2212x1661px; camera: Topcon TRC-NW400:
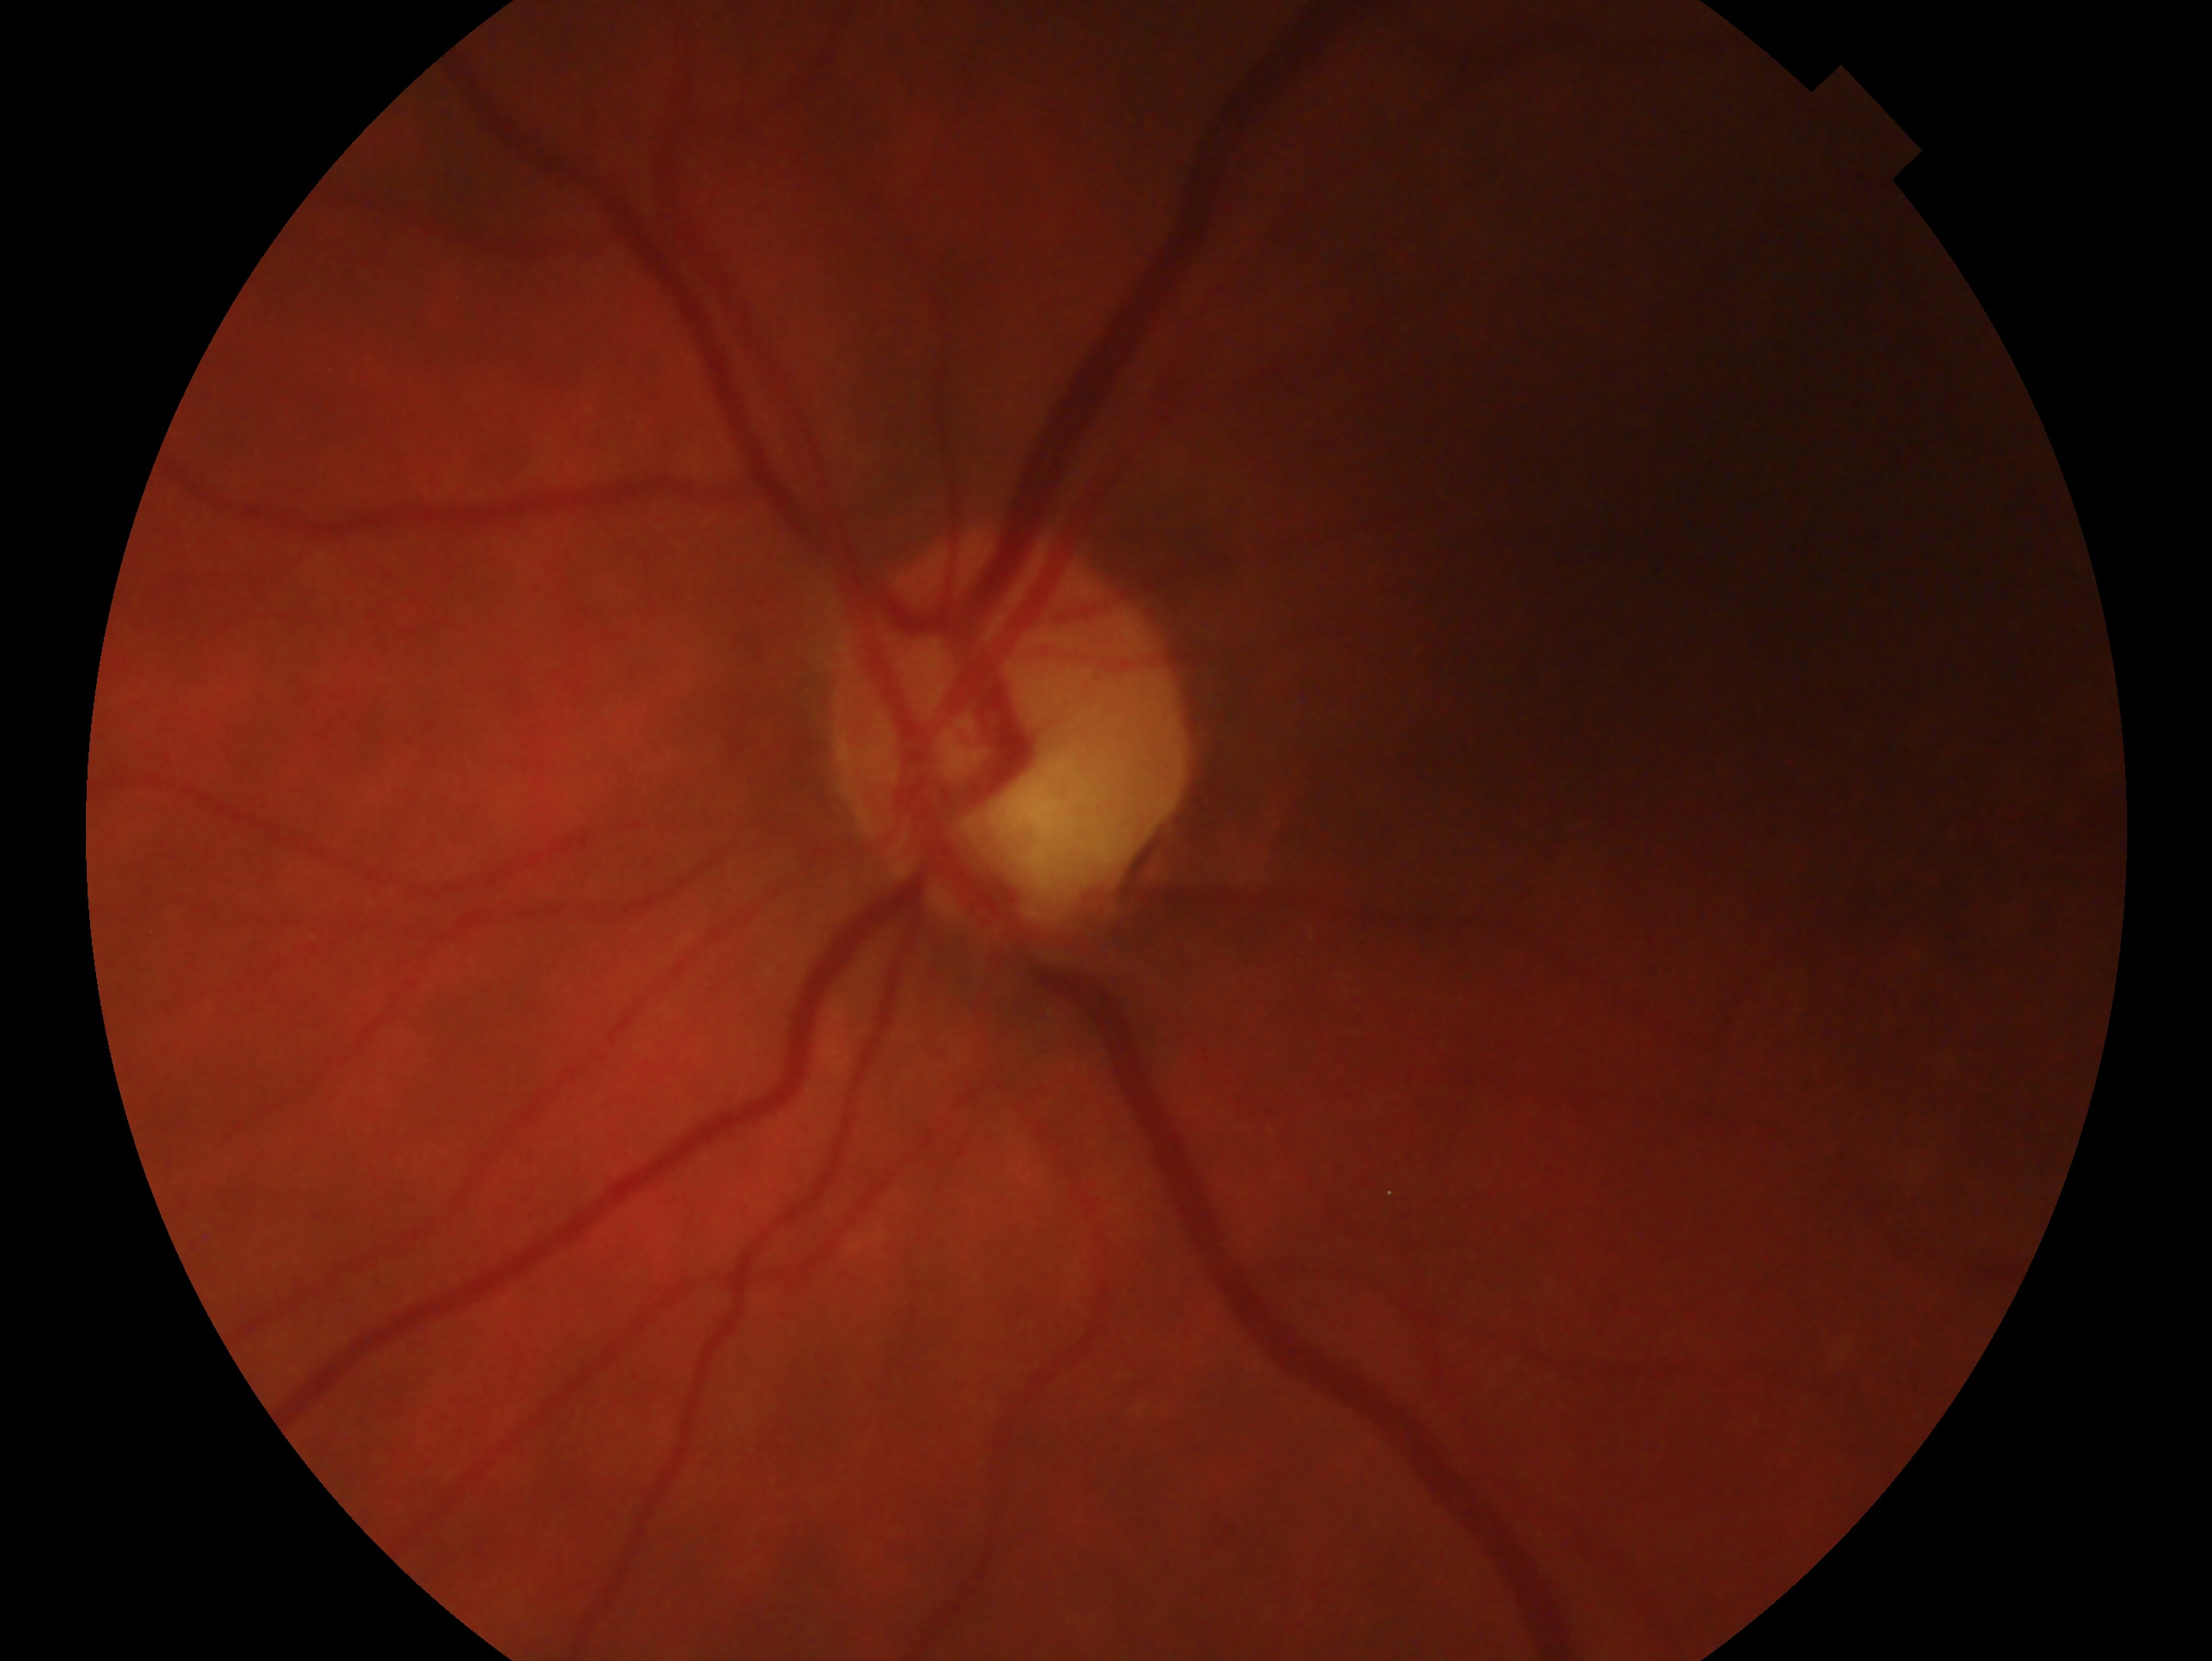
Eye: OS. Glaucoma assessment — glaucoma.